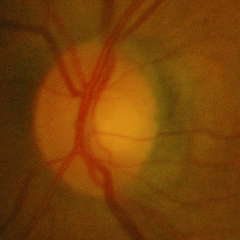 Findings consistent with no glaucoma.